Camera: NIDEK AFC-230 — 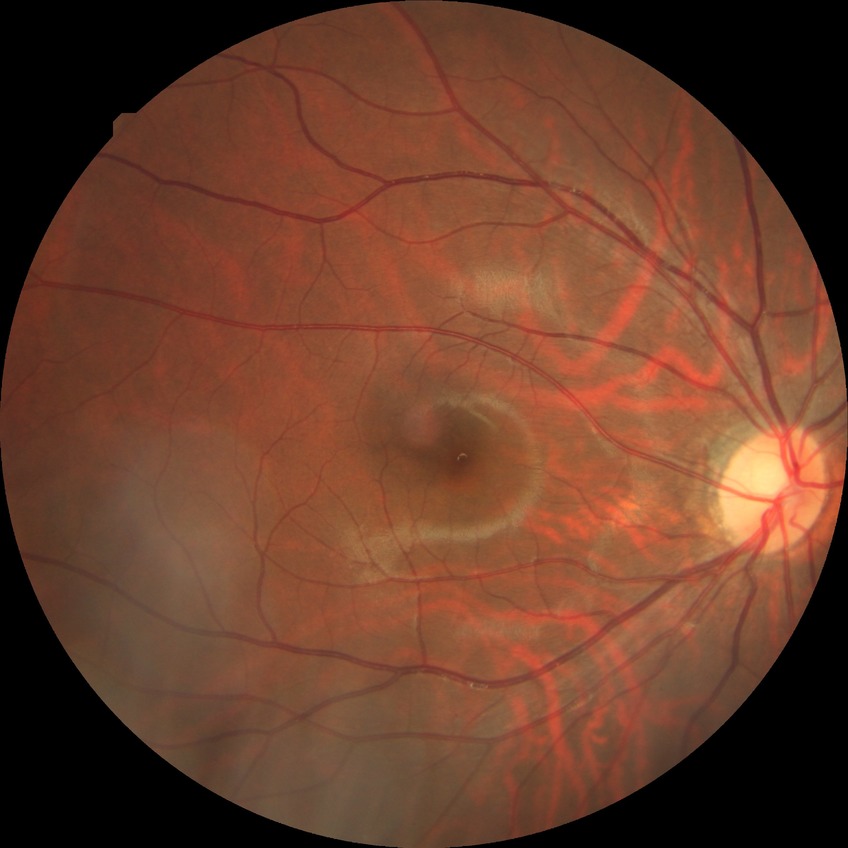

Diabetic retinopathy (DR): SDR (simple diabetic retinopathy).
DR class: non-proliferative diabetic retinopathy.